Modified Davis classification: 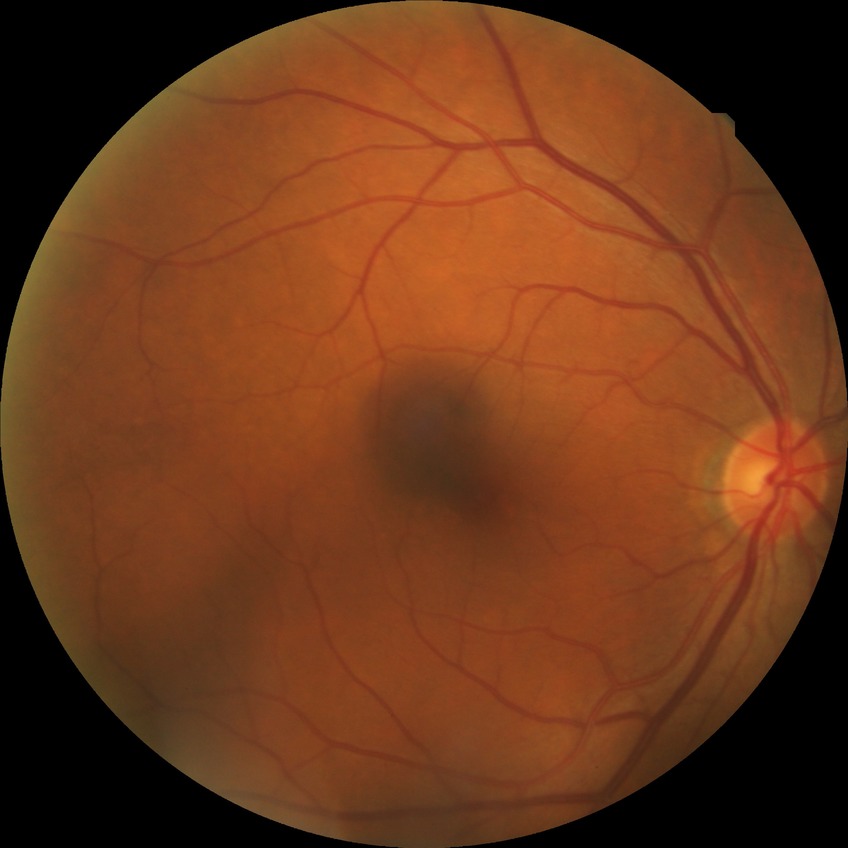

DR severity: NDR.
No diabetic retinal disease findings.